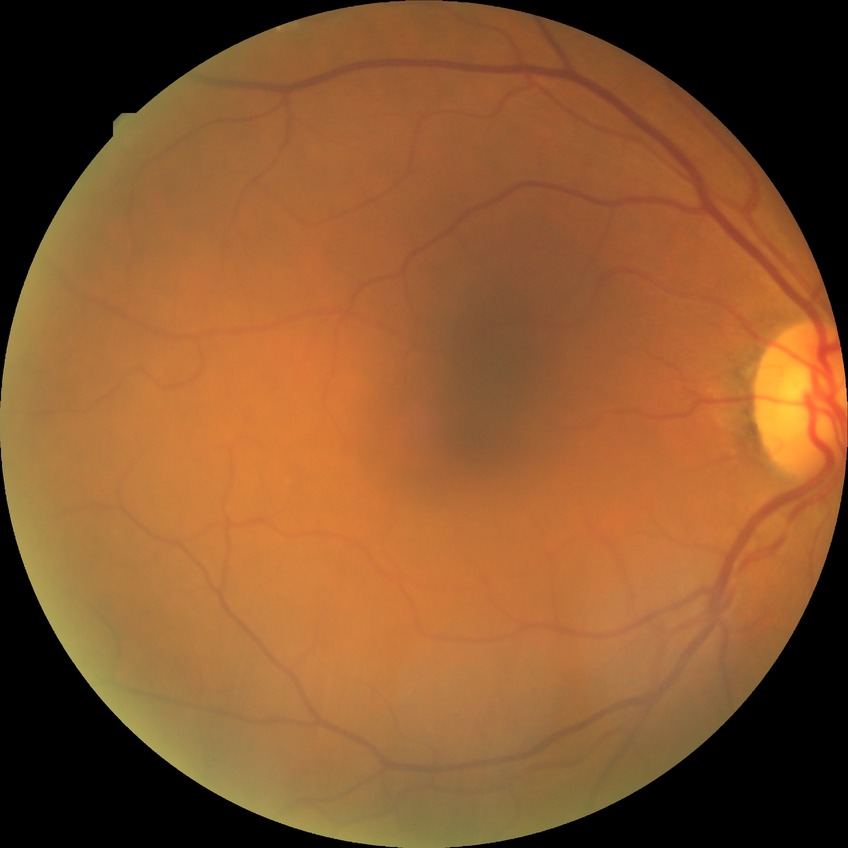
diabetic retinopathy (DR) = no diabetic retinopathy (NDR).